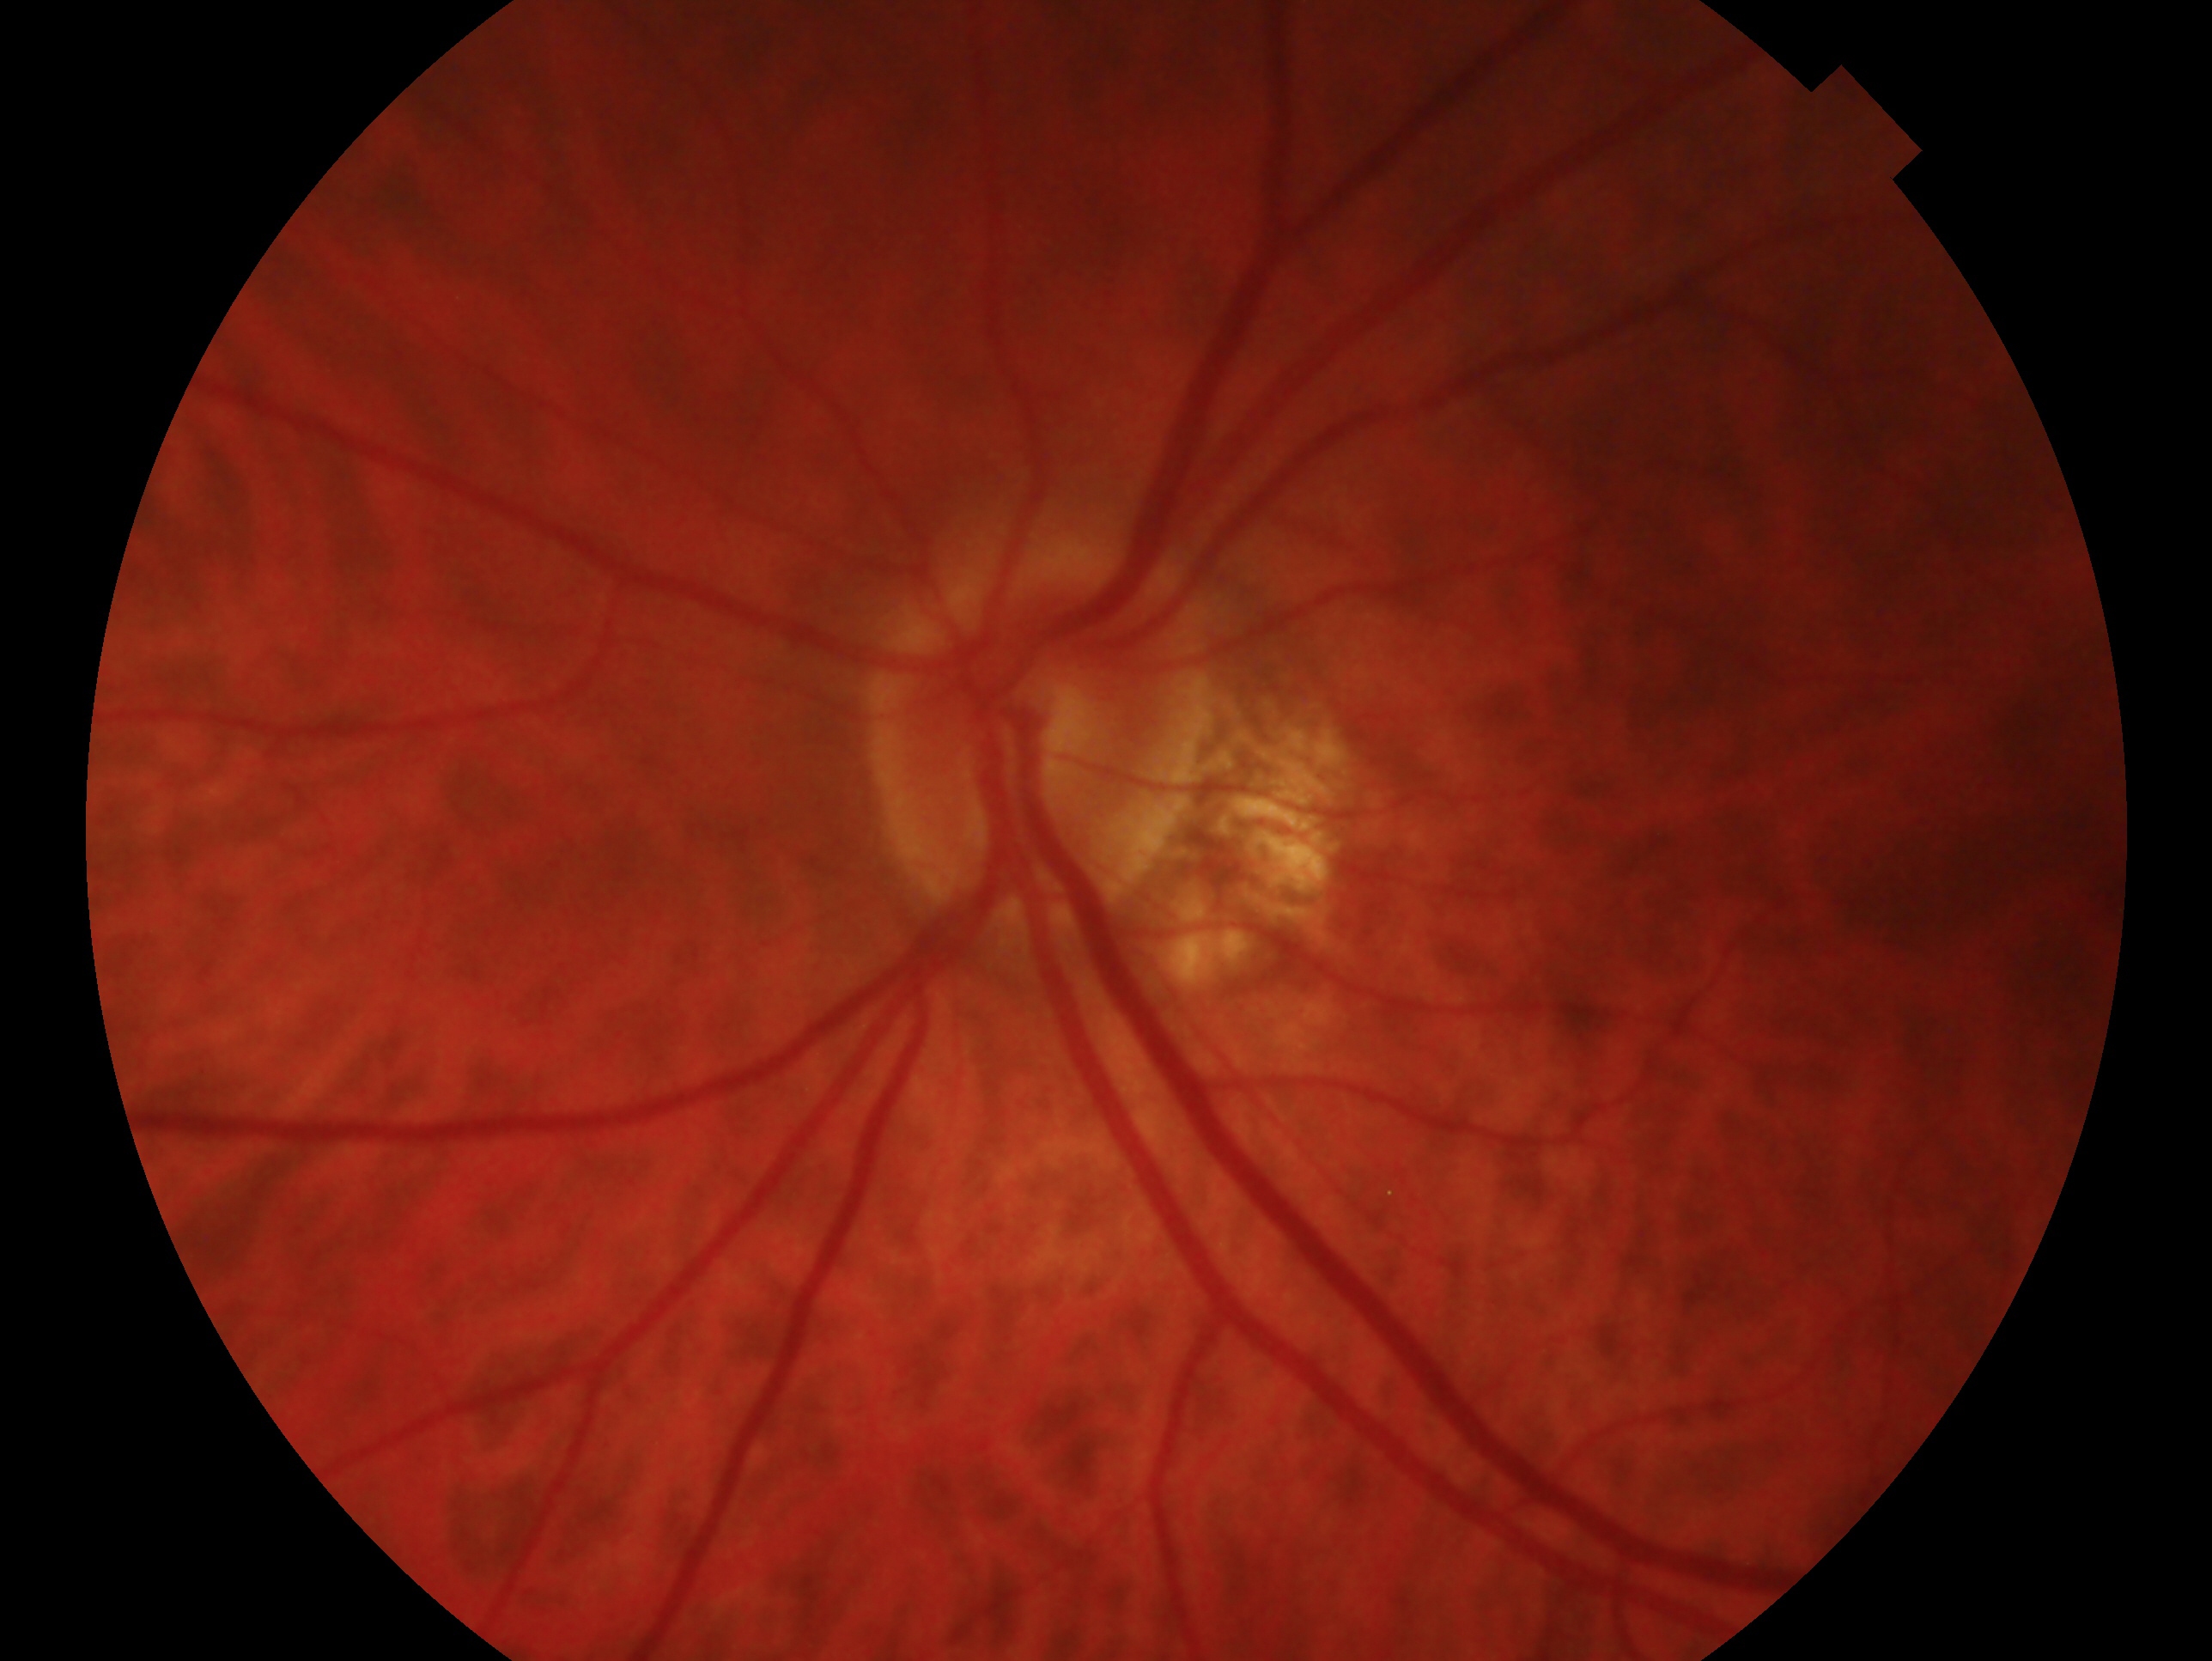 {
  "glaucoma_dx": "possible glaucoma",
  "eye": "left"
}